Color fundus image:
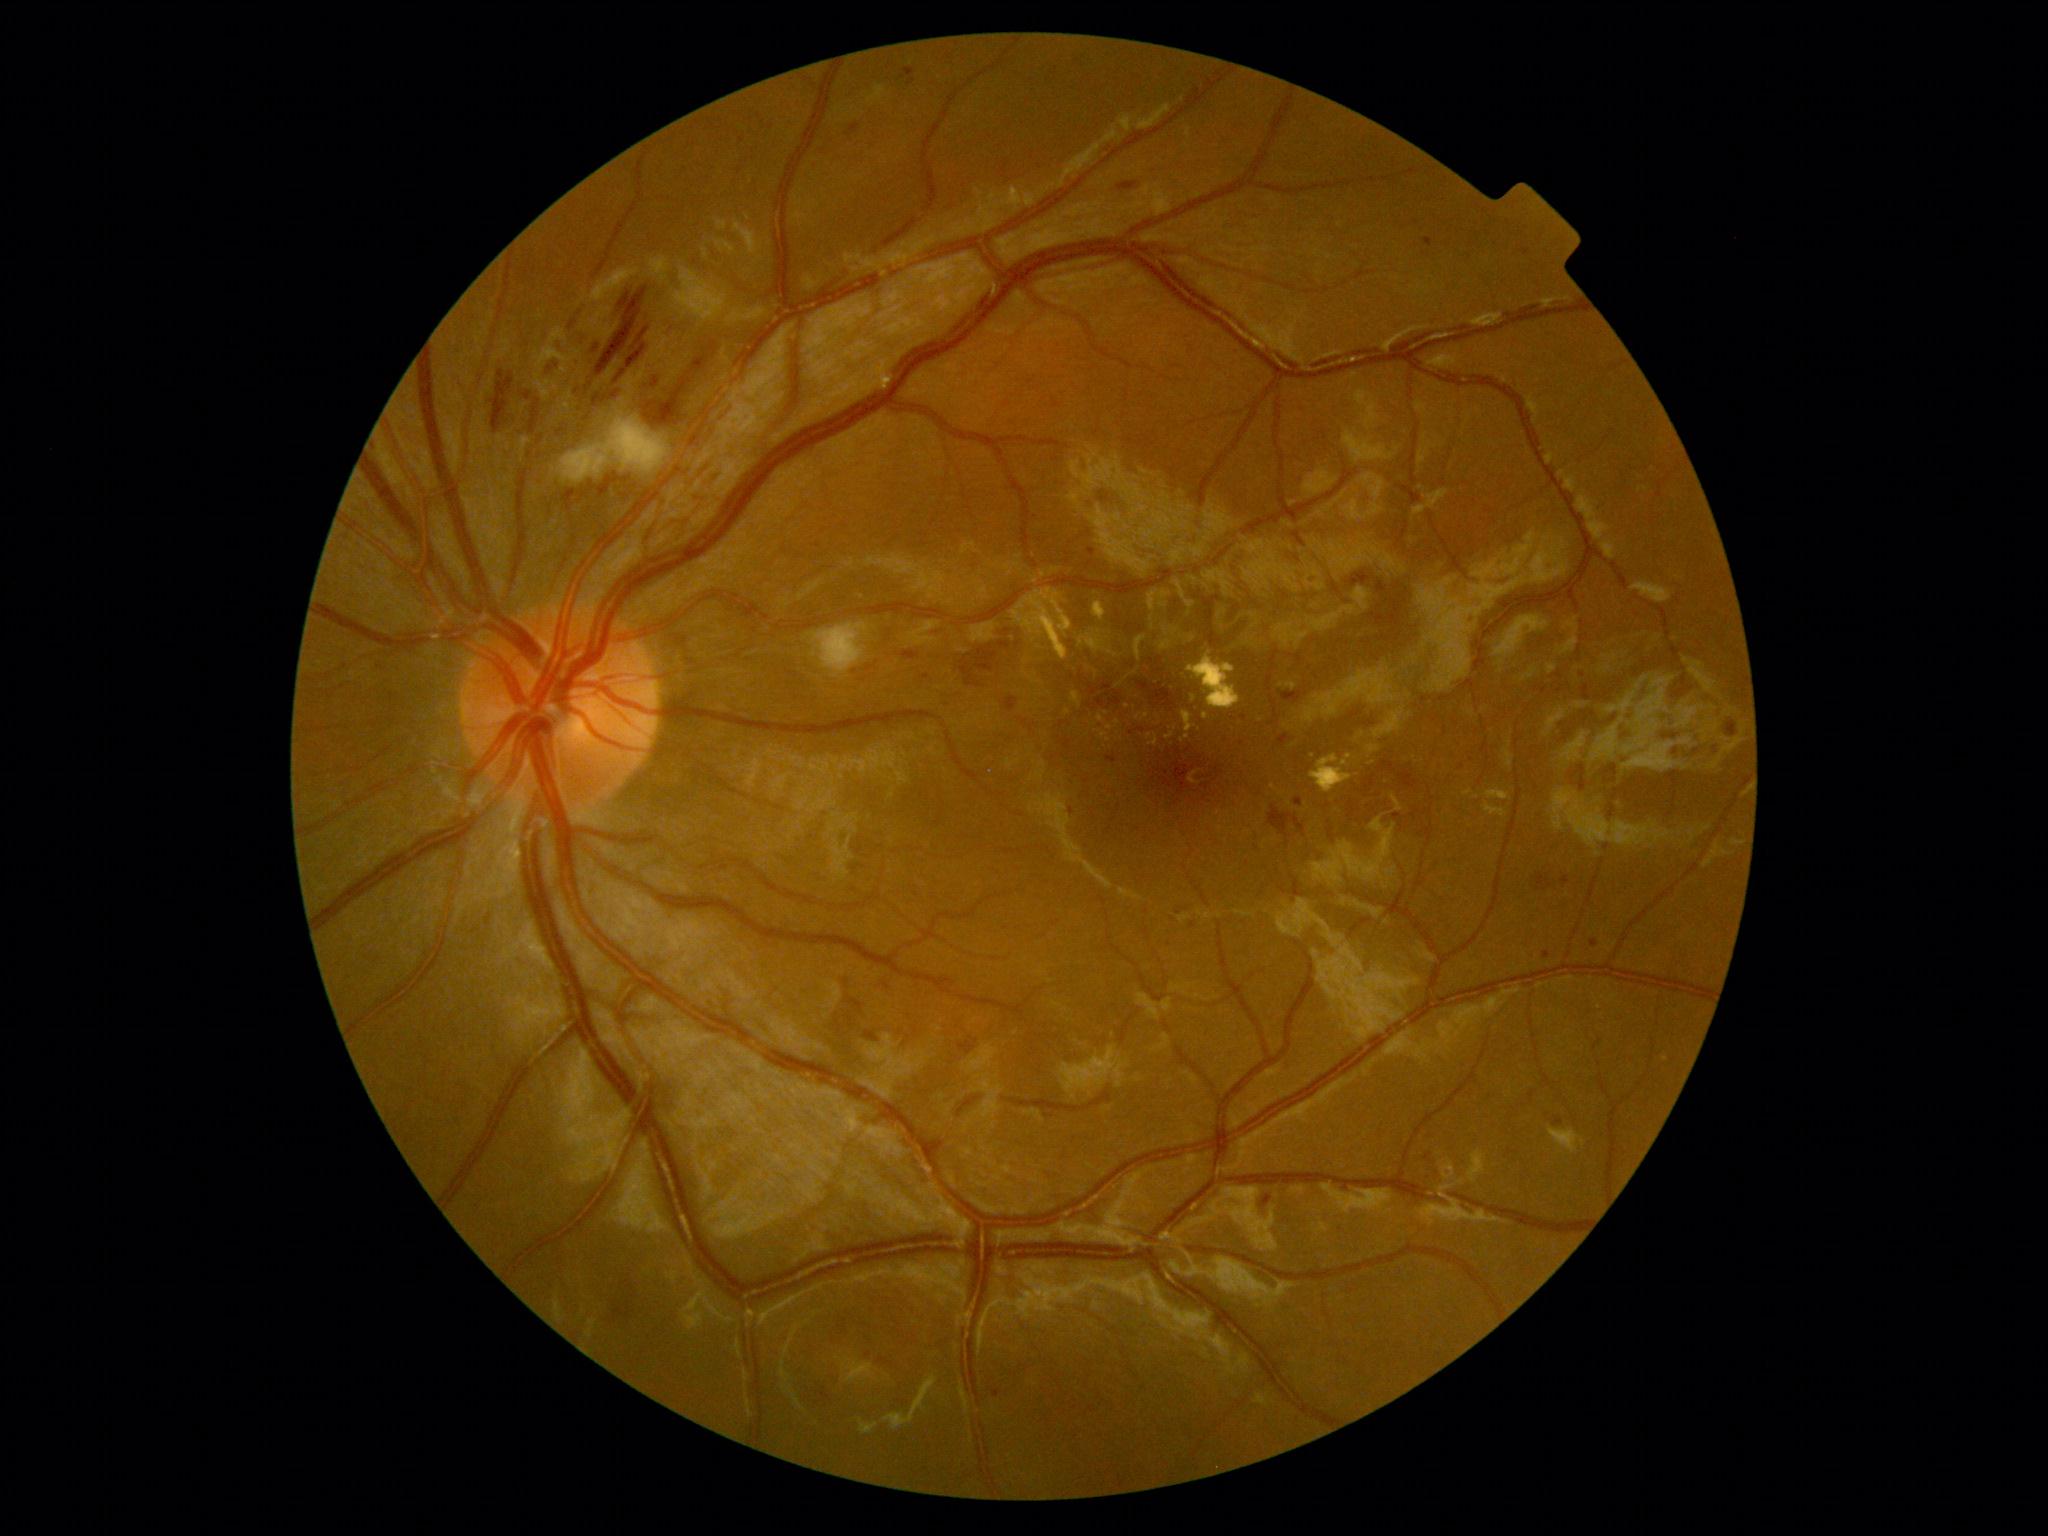
diabetic retinopathy grade: moderate non-proliferative diabetic retinopathy (2).